CFP, camera: NIDEK AFC-230, modified Davis classification, 848 x 848 pixels
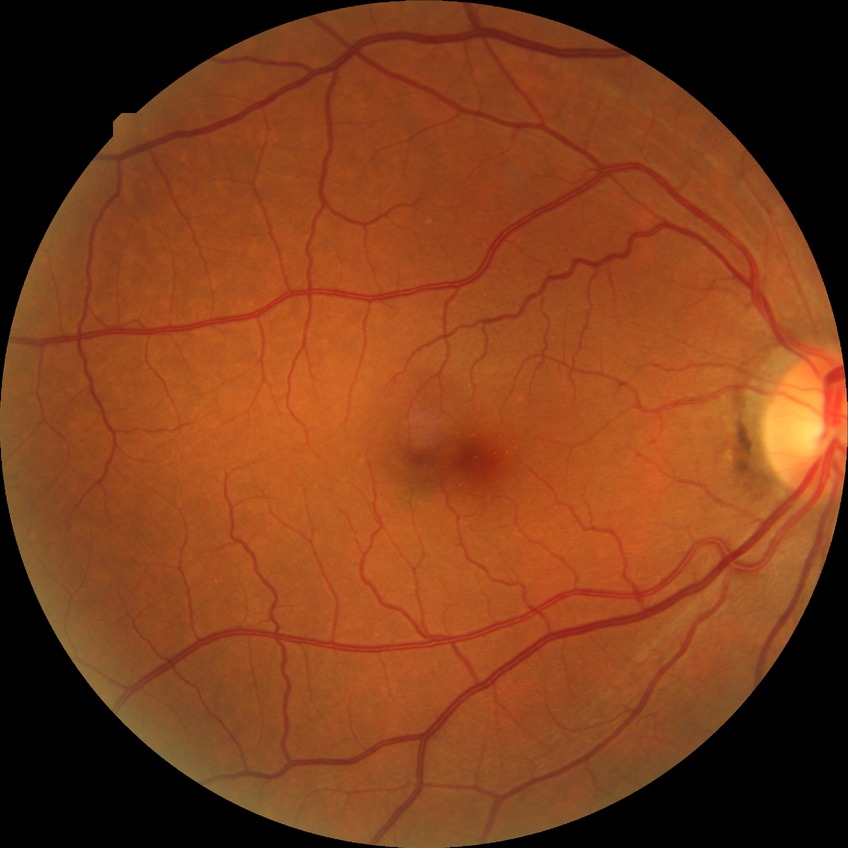 Davis grading: no diabetic retinopathy.